Fundus photo.
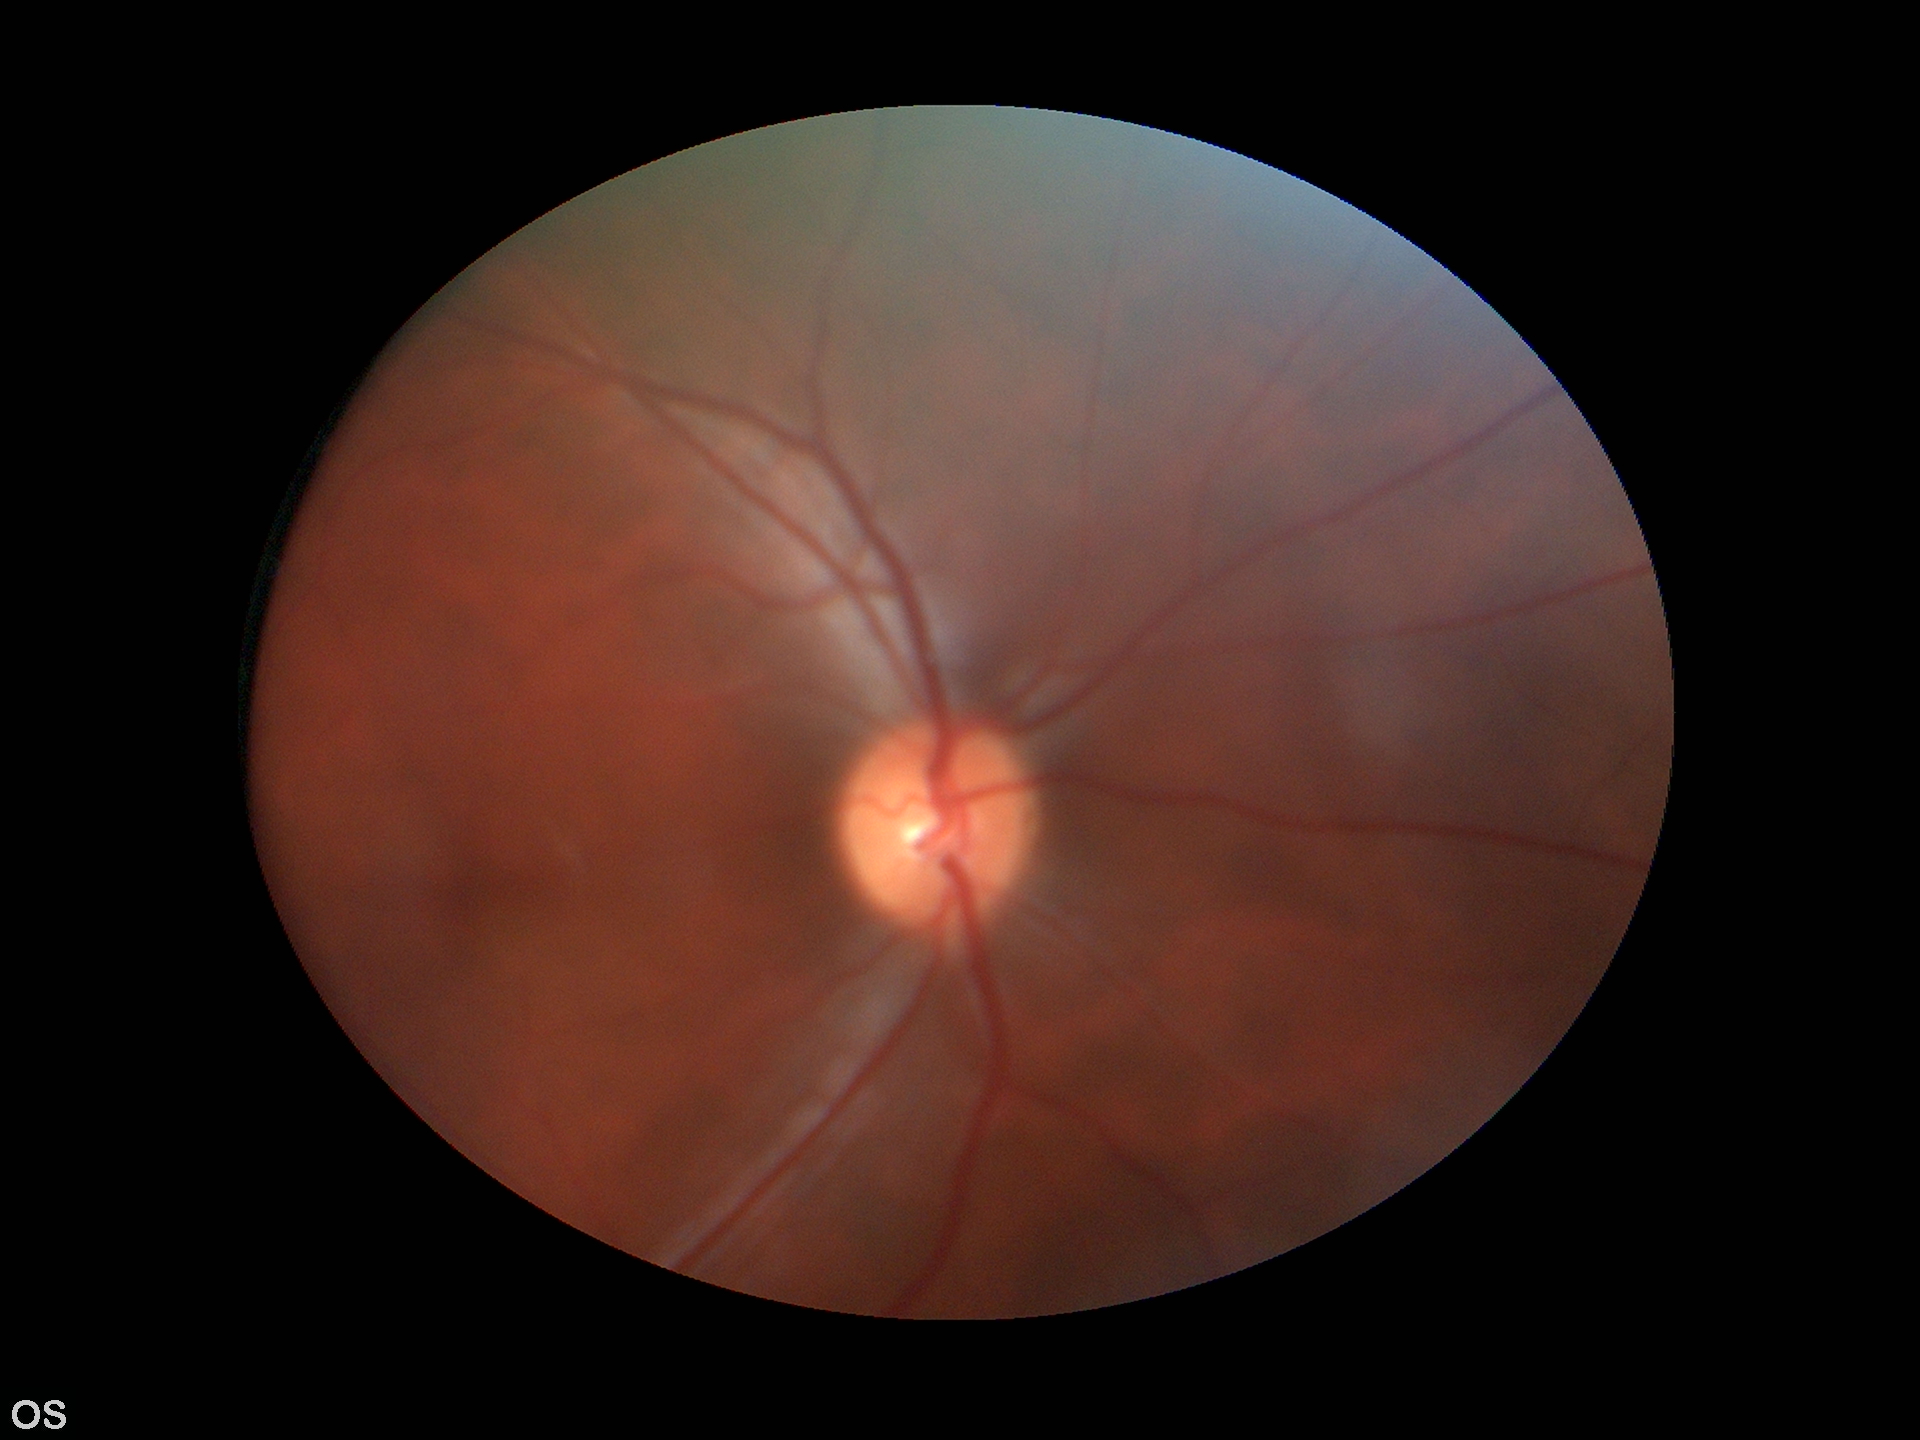
Glaucoma decision: no suspicious findings.
Area CDR (ACDR): 0.20.
Horizontal CDR (HCDR): 0.46.
Vertical cup-to-disc ratio (VCDR) is 0.44.